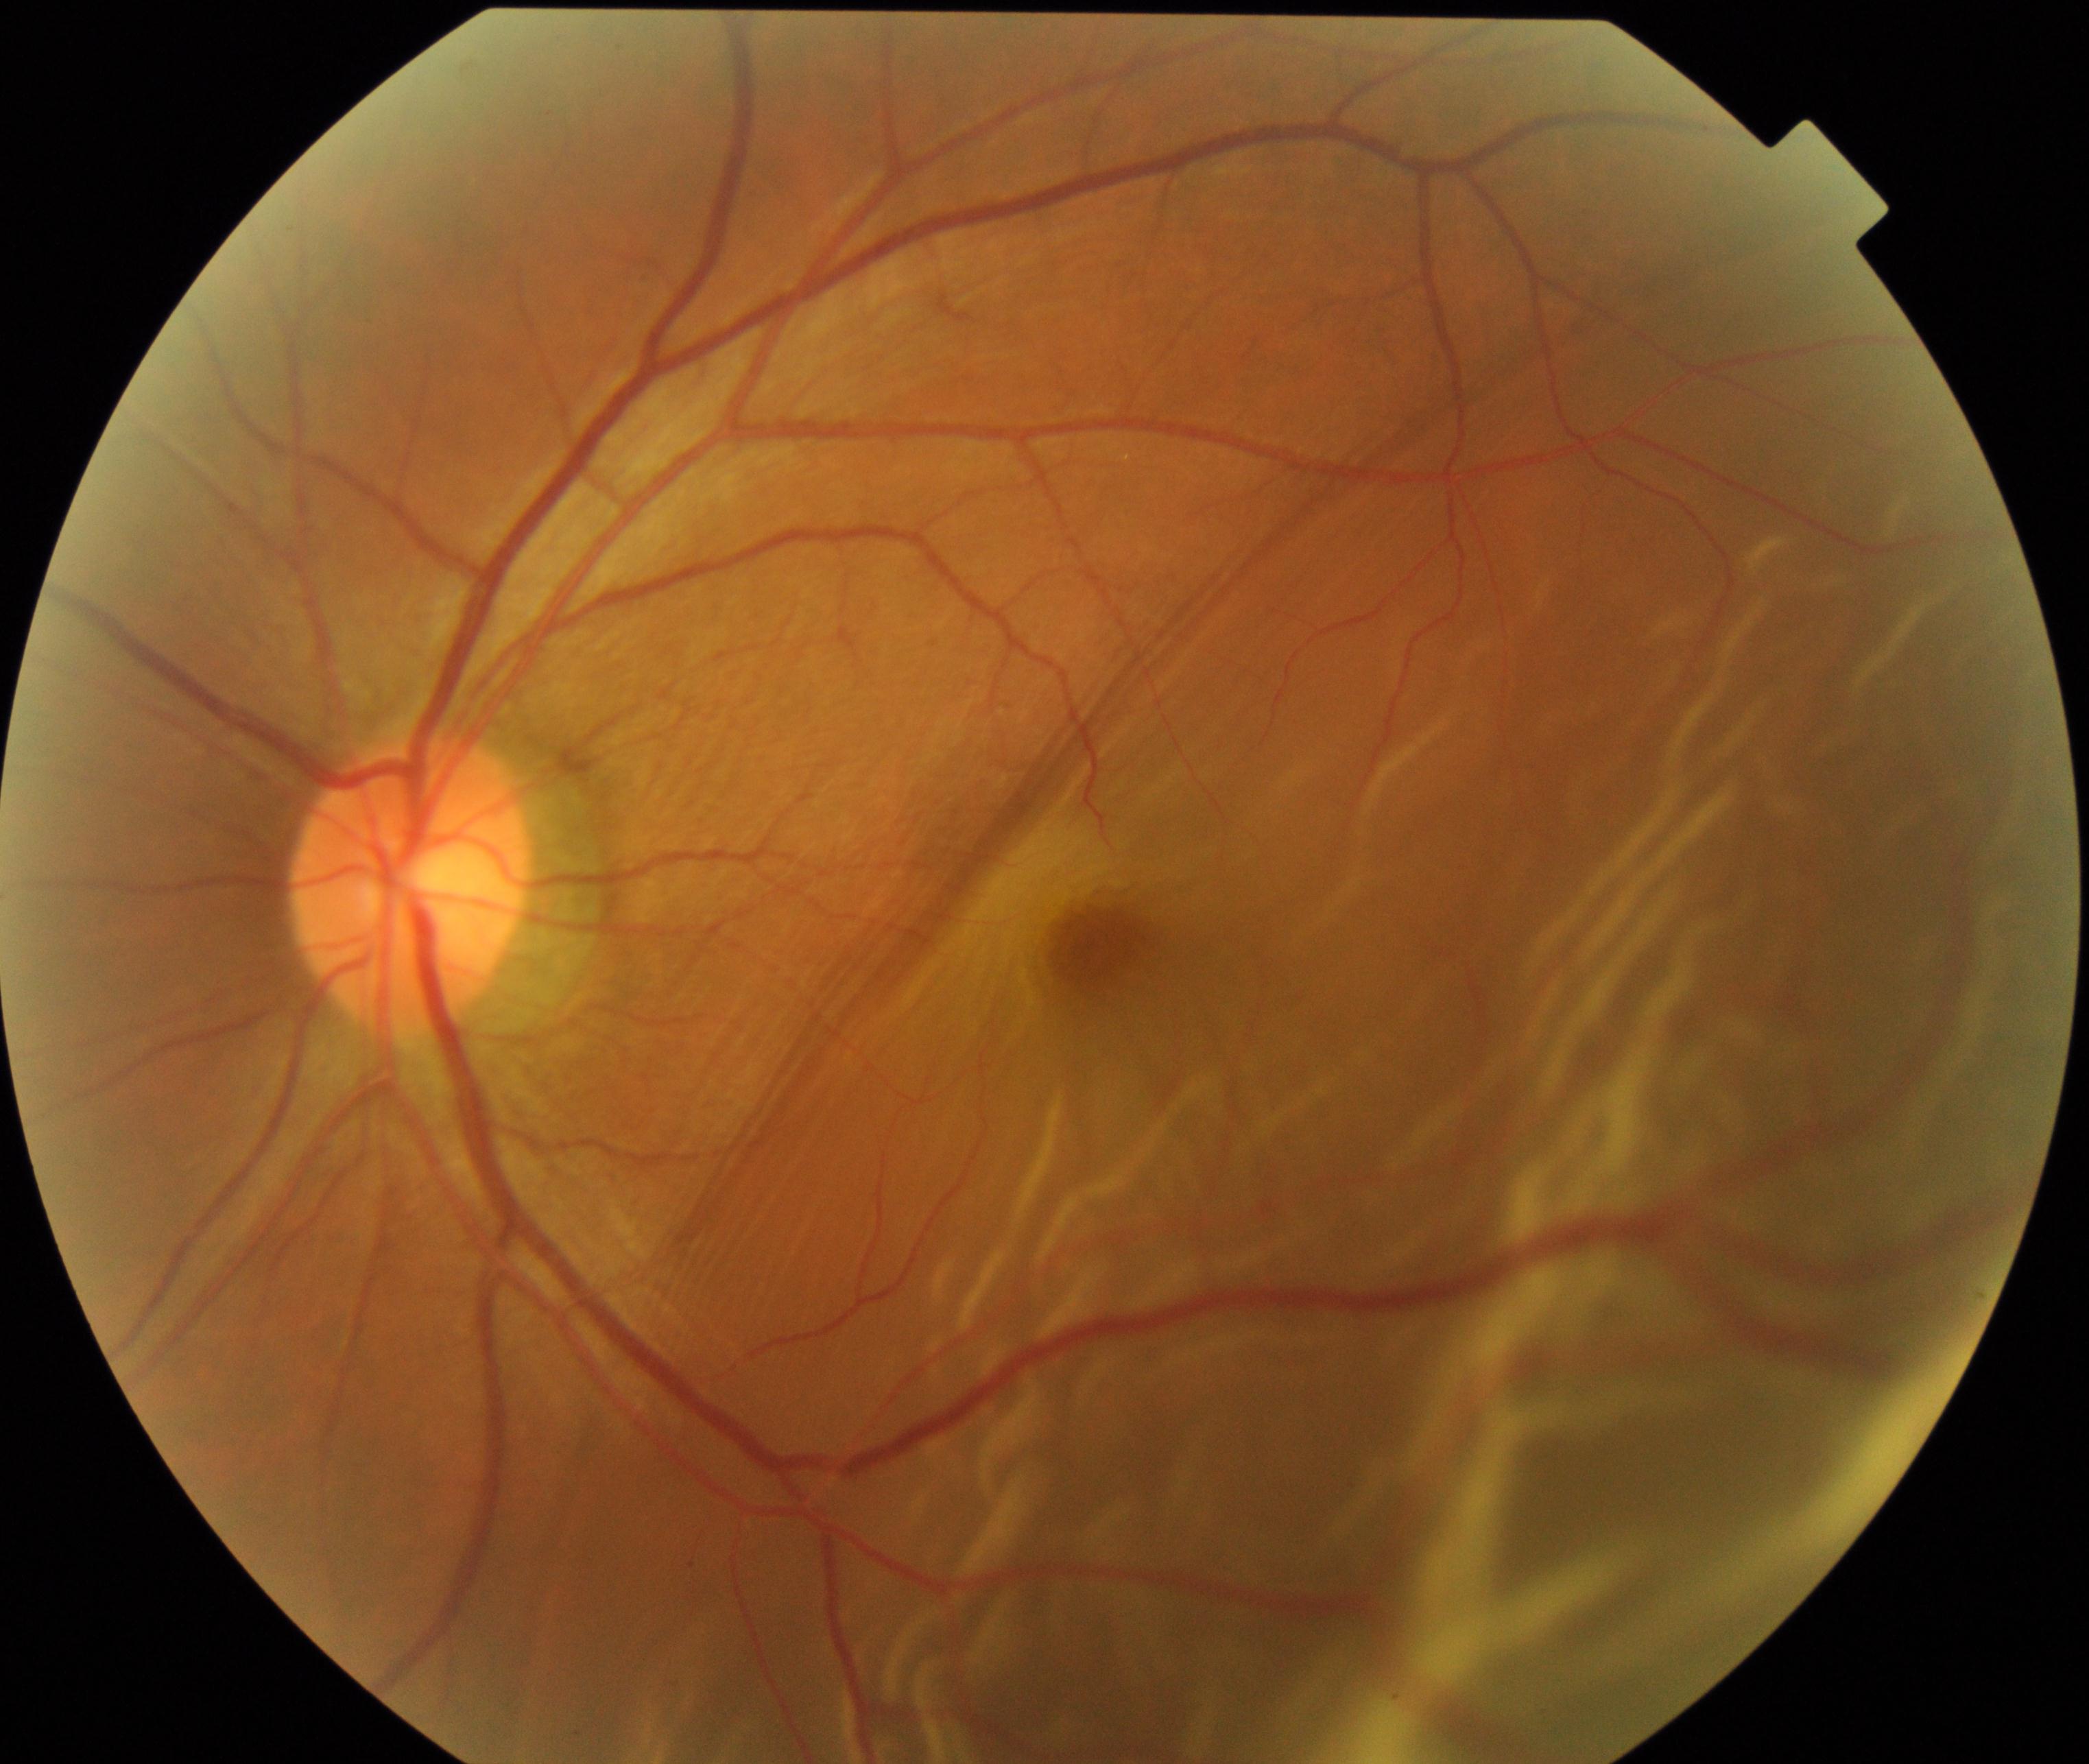
This fundus photograph shows rhegmatogenous retinal detachment. Characterized by slightly opaque, convex or corrugated appearance of elevated retina, sometimes with retinal breaks in view.